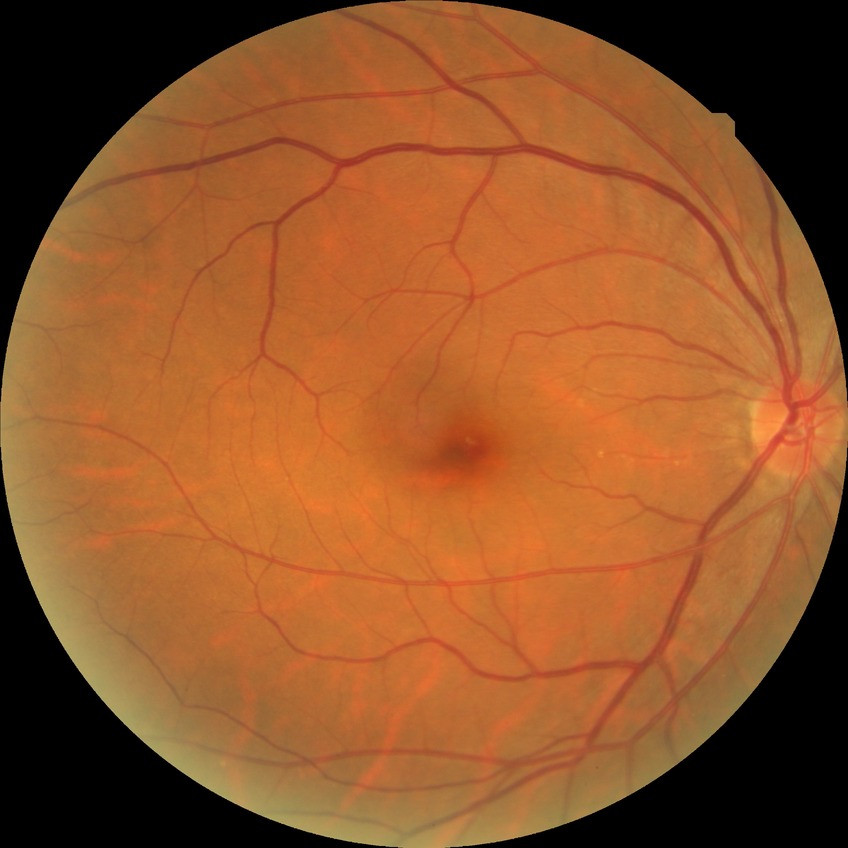 diabetic retinopathy (DR) = NDR (no diabetic retinopathy).